2352x1568px · 45-degree field of view · color fundus photograph.
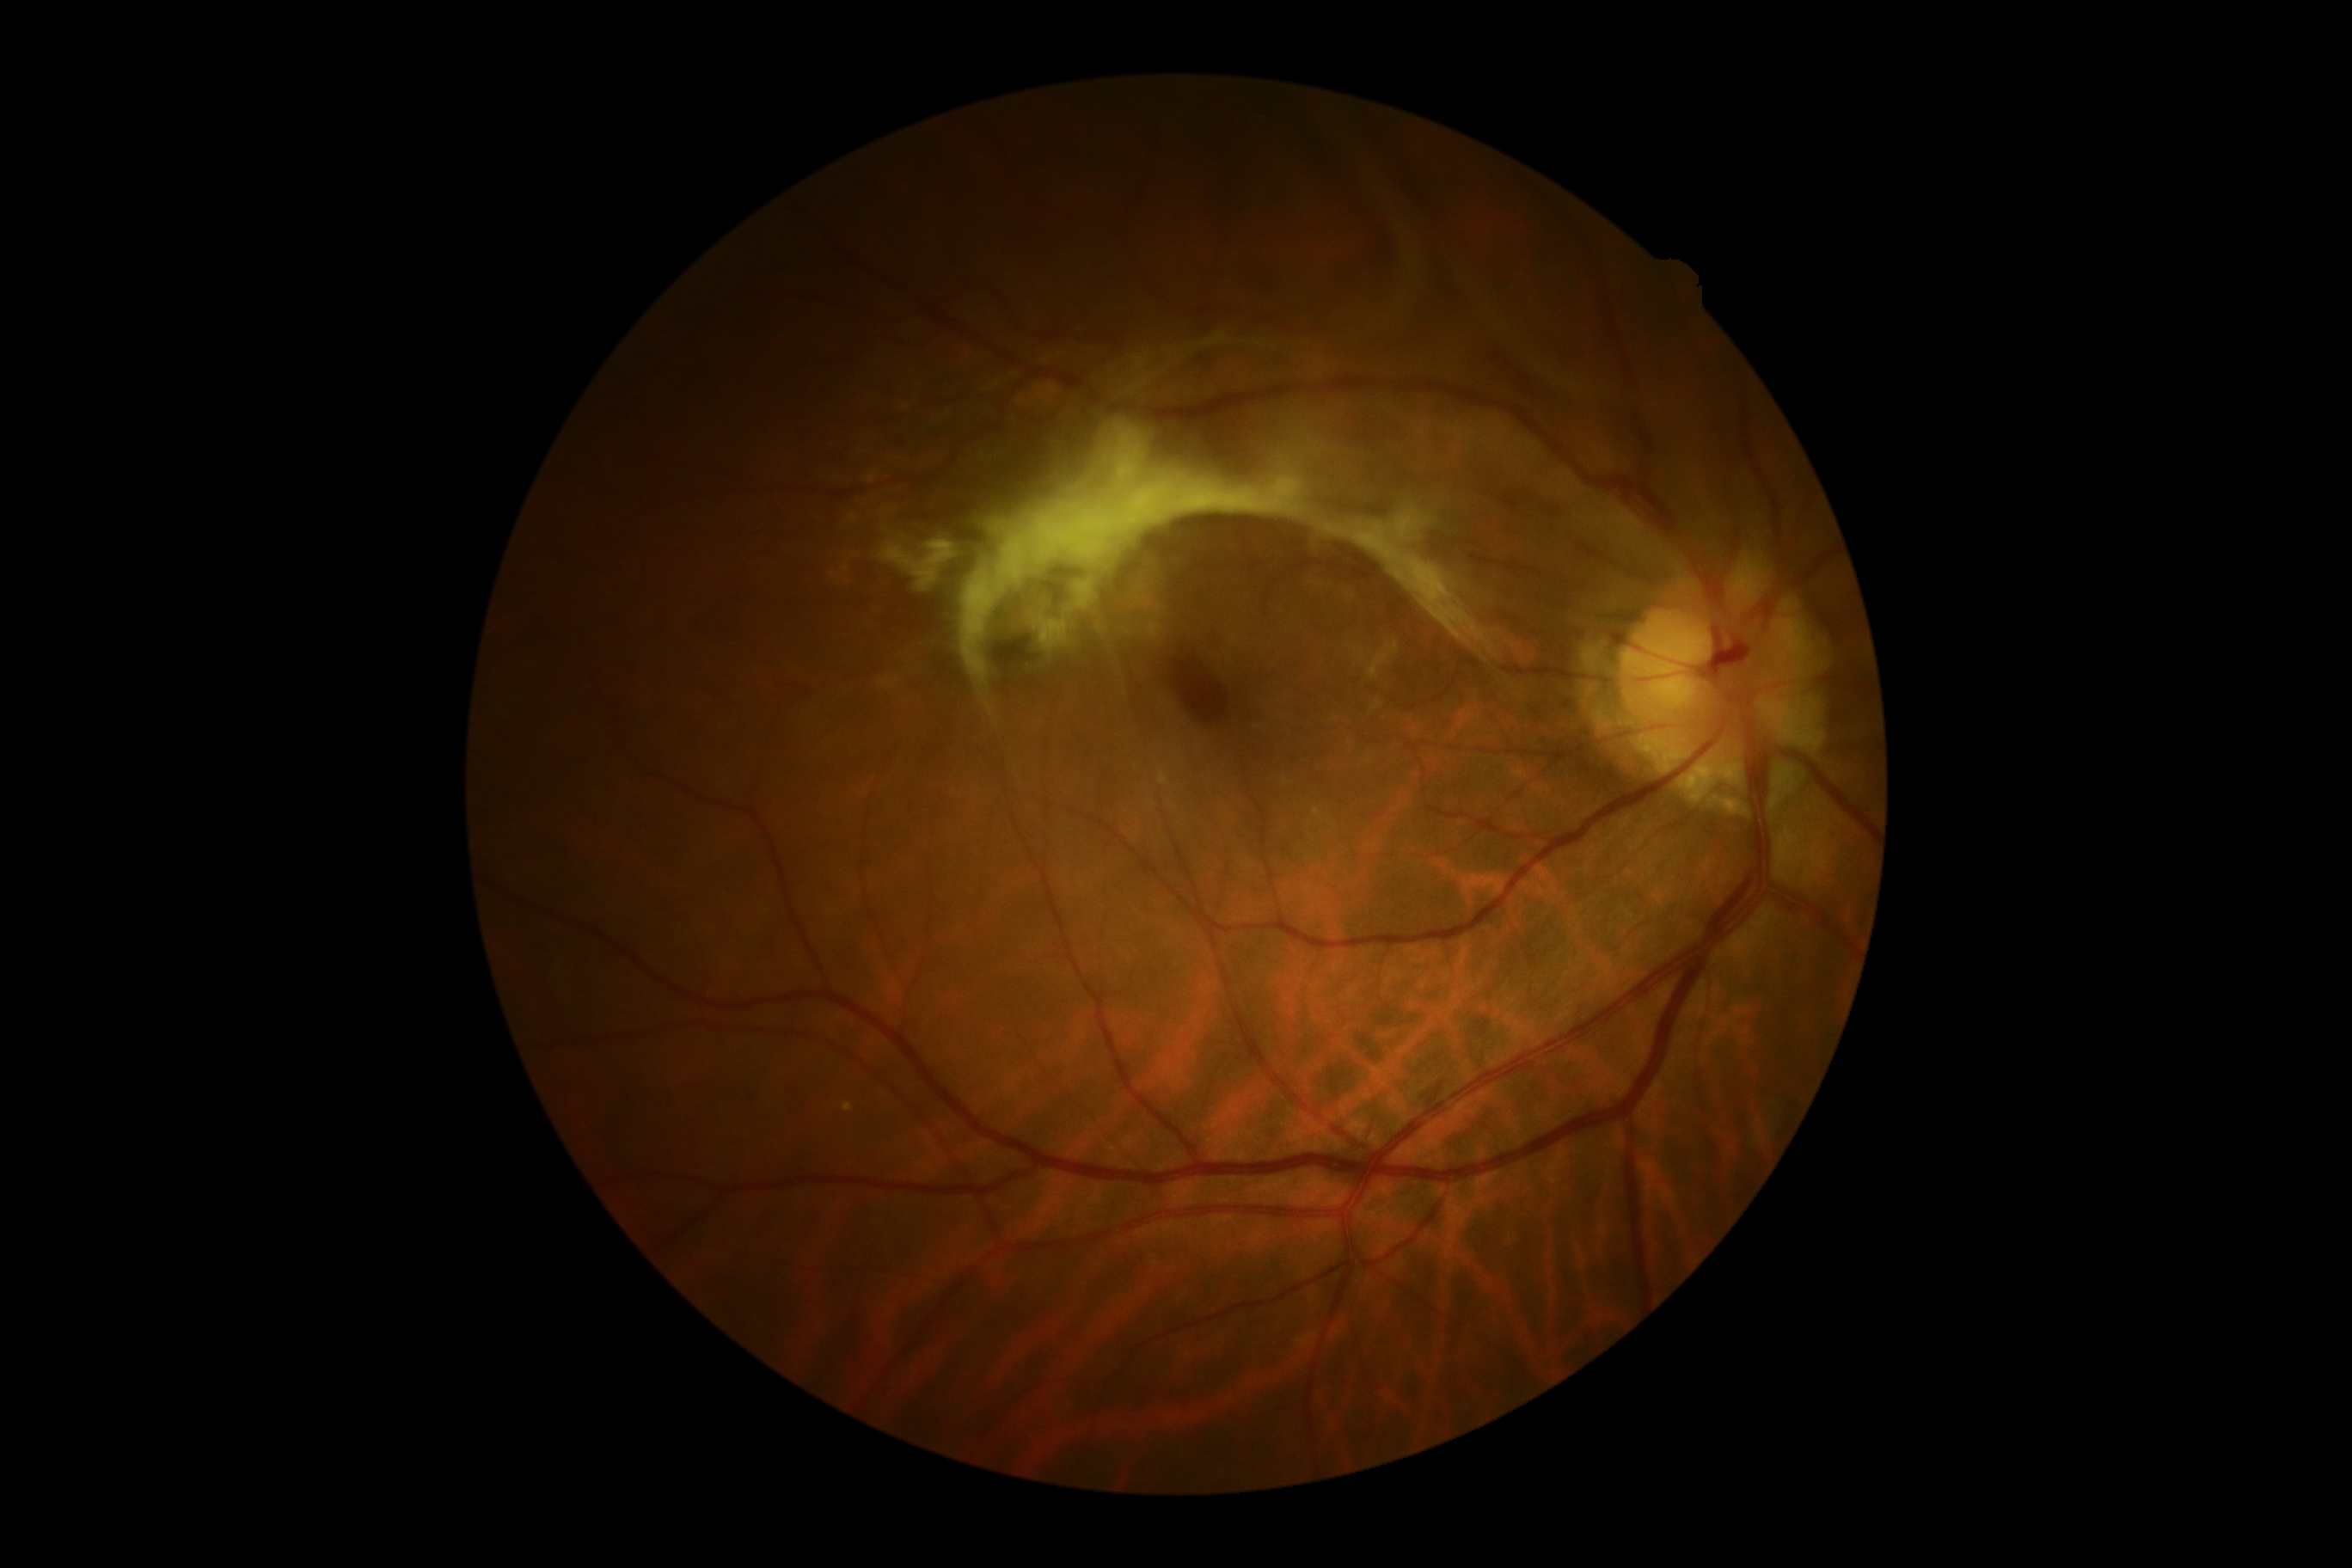
DR severity: 4/4.